45° FOV, color fundus image: 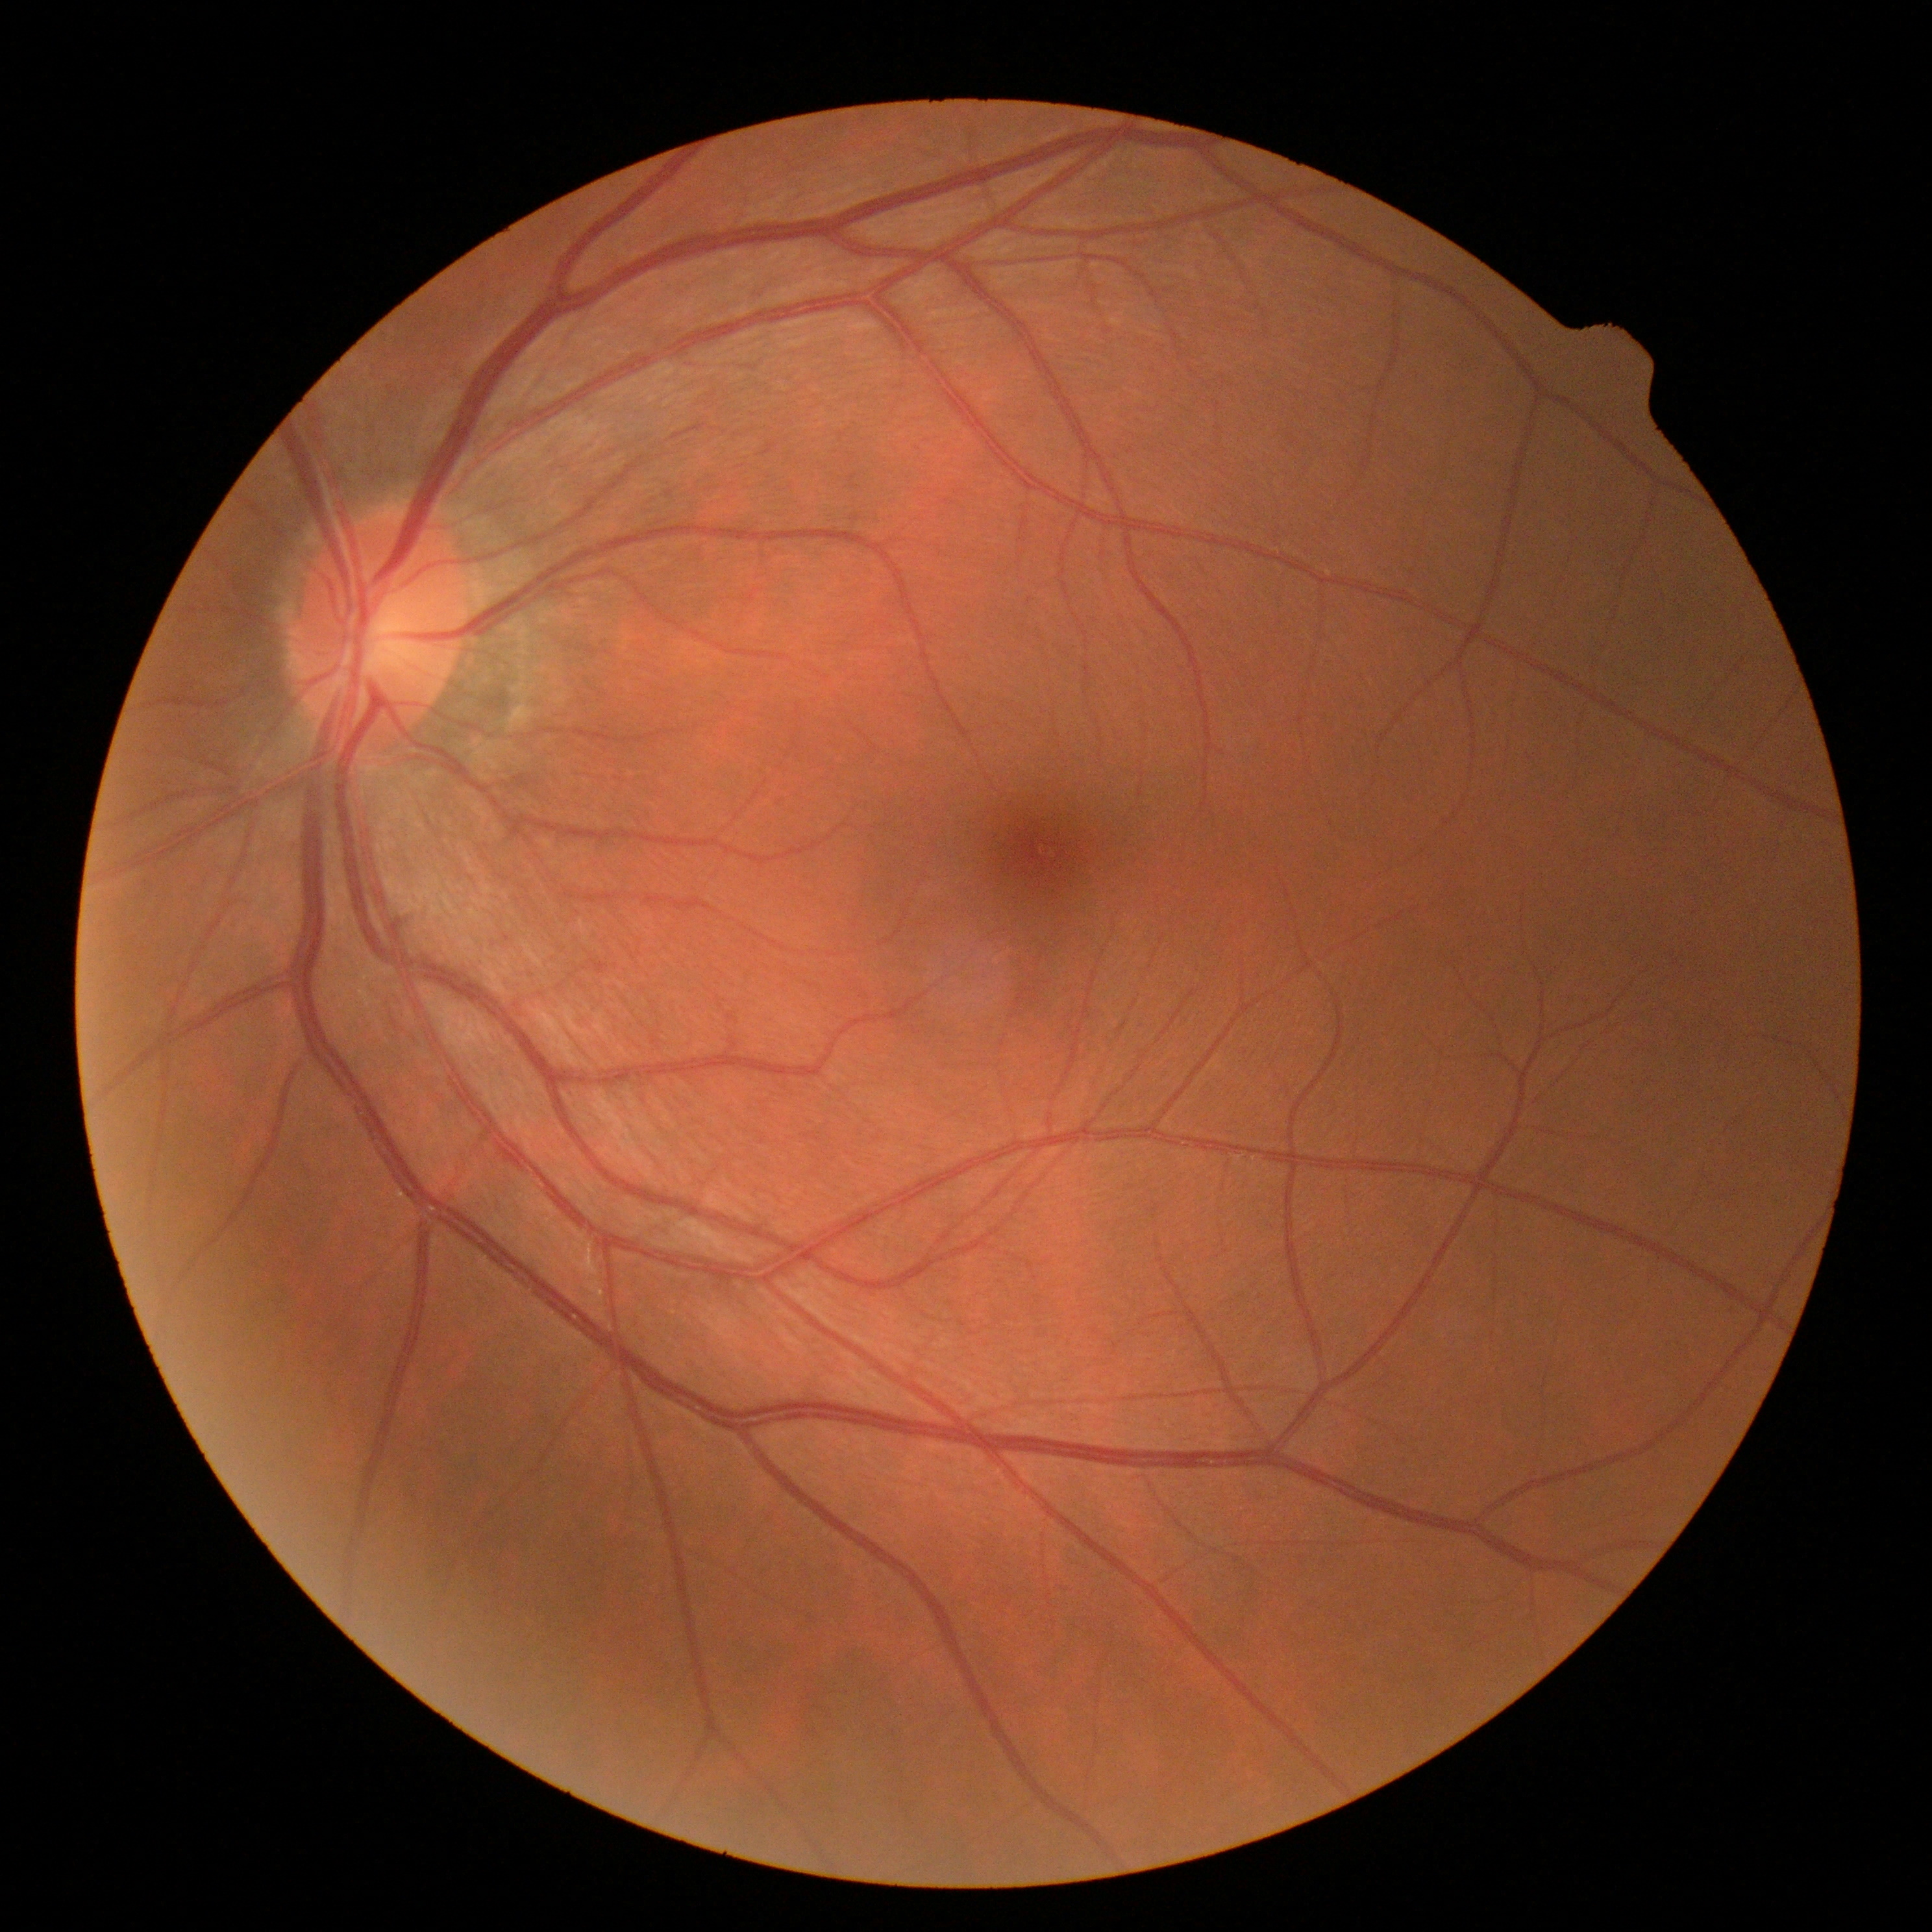 Diabetic retinopathy grade is 0.